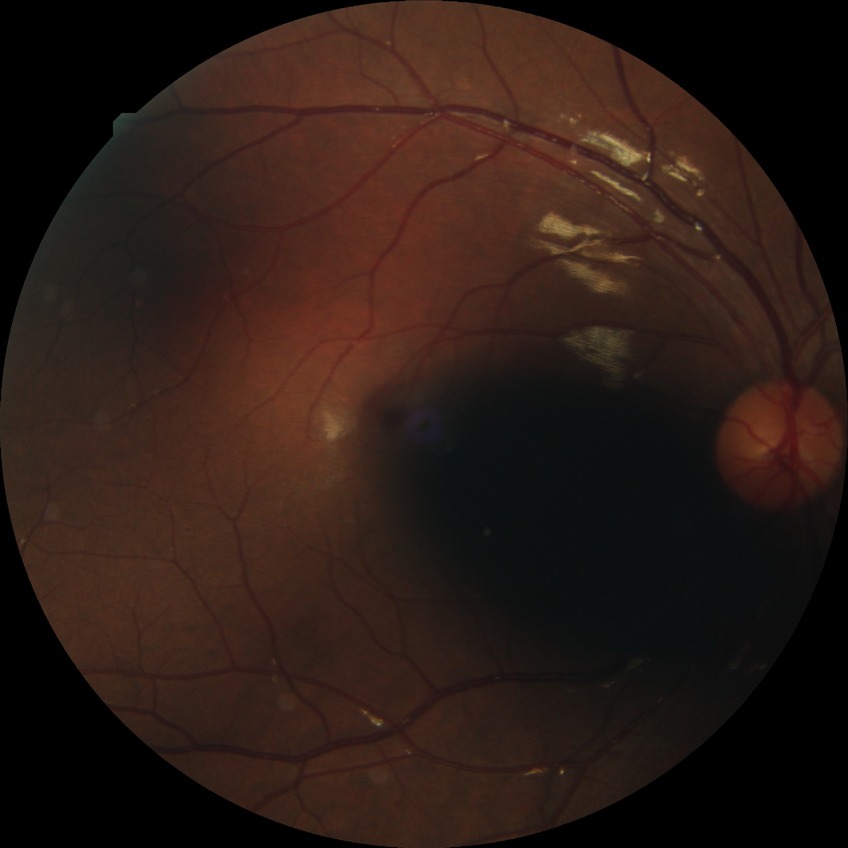
Annotations:
– Davis stage — SDR